Infant wide-field retinal image — 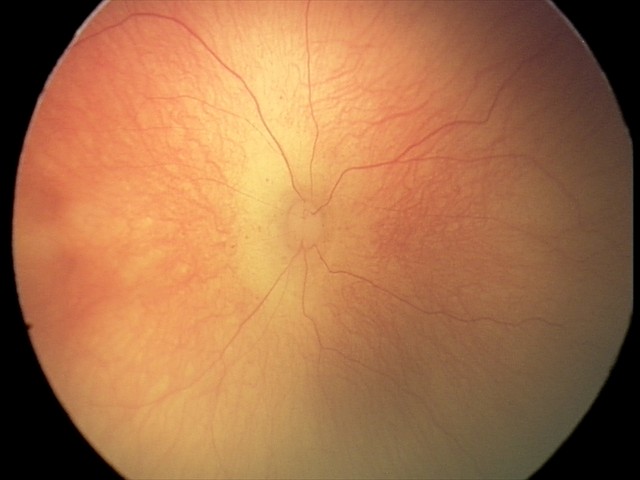

Impression: ROP stage 0 — incomplete retinal vascularization without a demarcation line.